50° FOV — 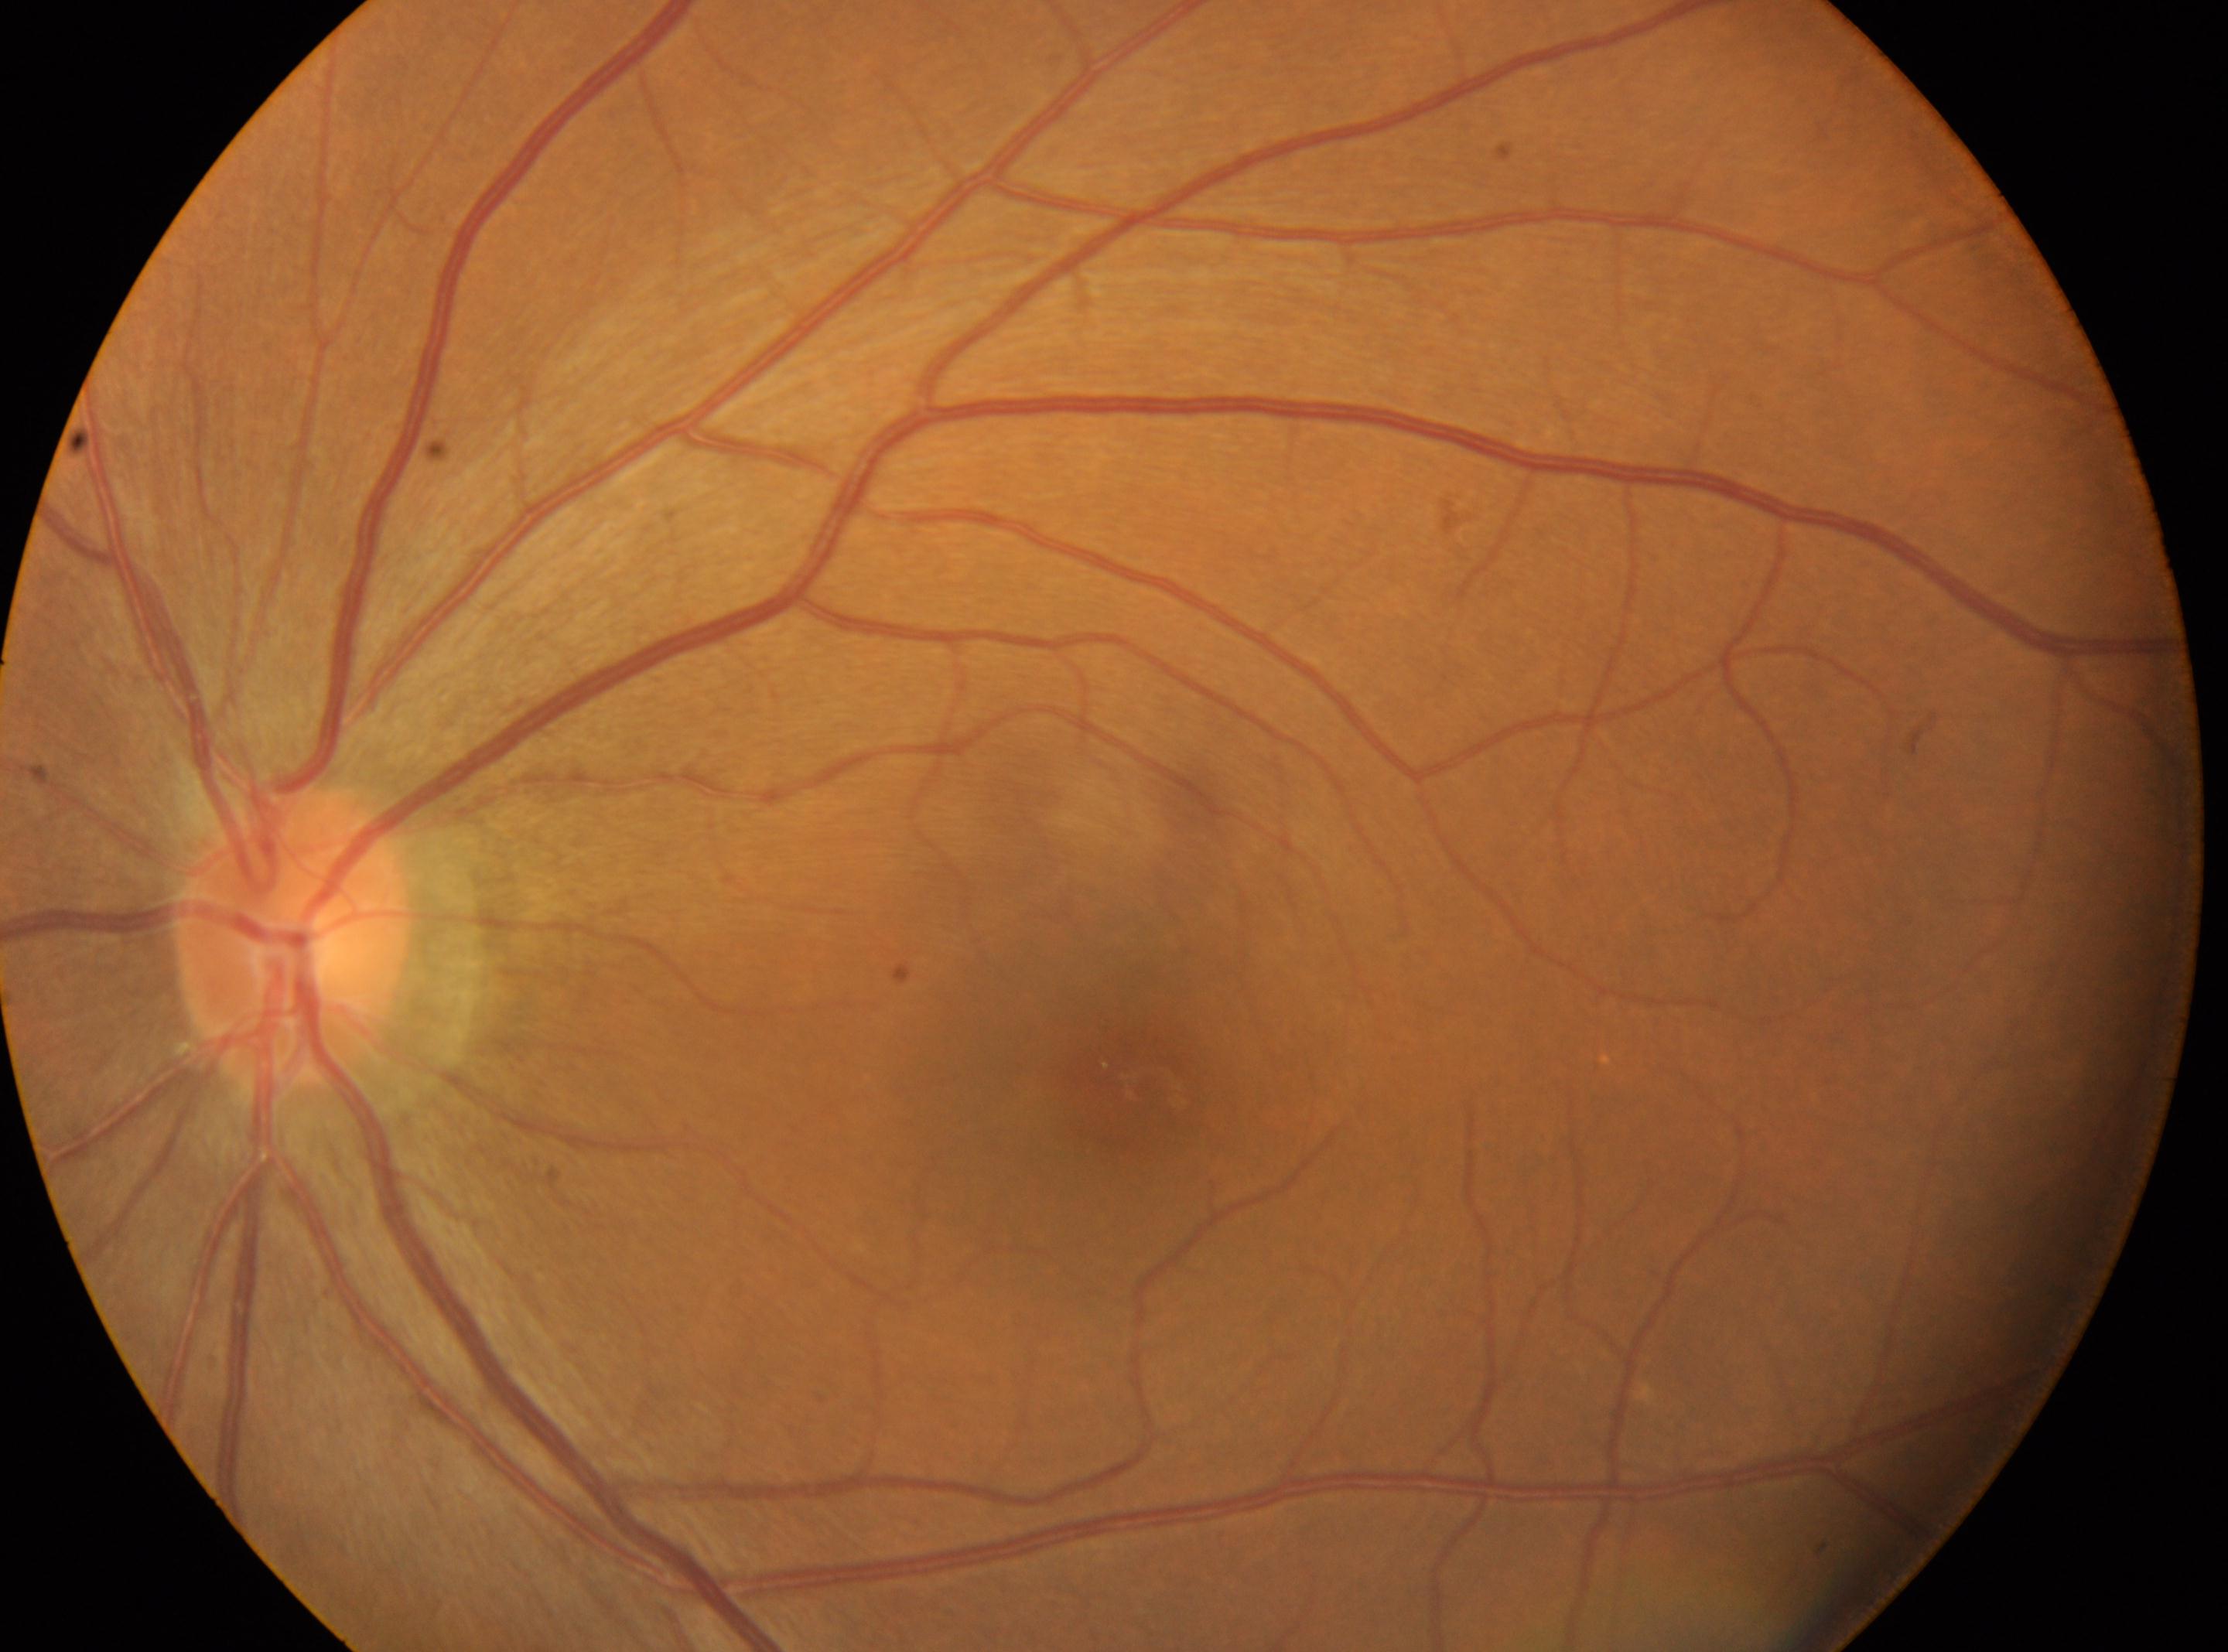

Diabetic retinopathy is grade 0.
This is the oculus sinister.
Foveal center located at x=1137, y=1084.
Optic disc located at x=294, y=940.
No apparent diabetic retinopathy.